Phoenix ICON wide-field infant fundus image. 100° field of view (Phoenix ICON)
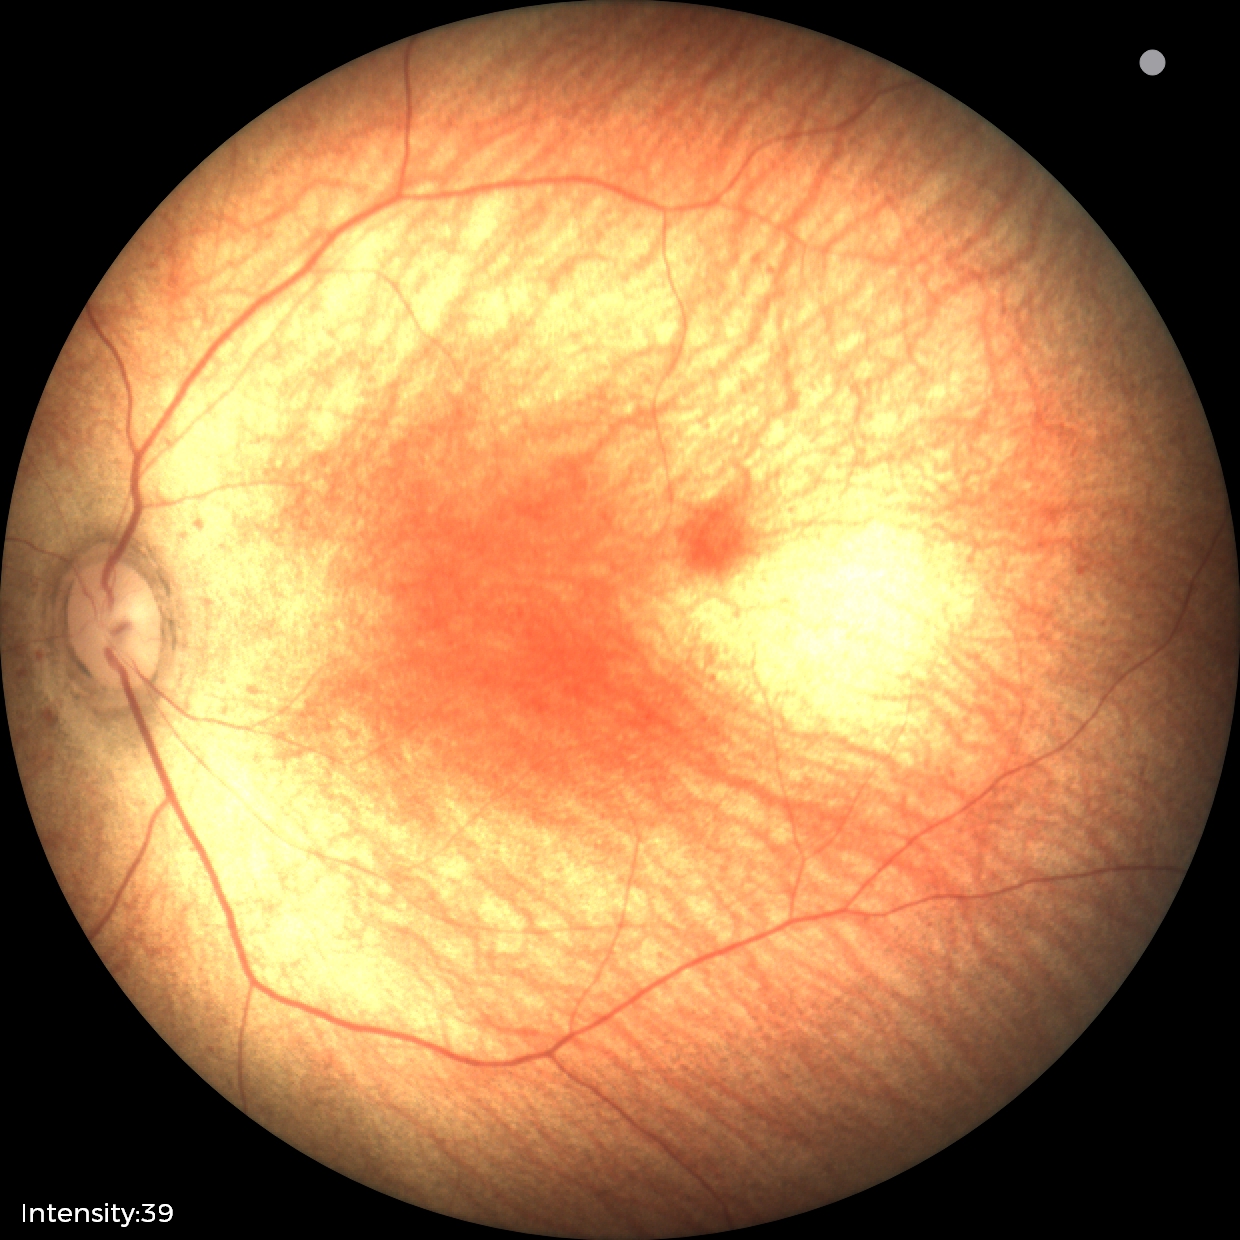

Diagnosis: physiological.